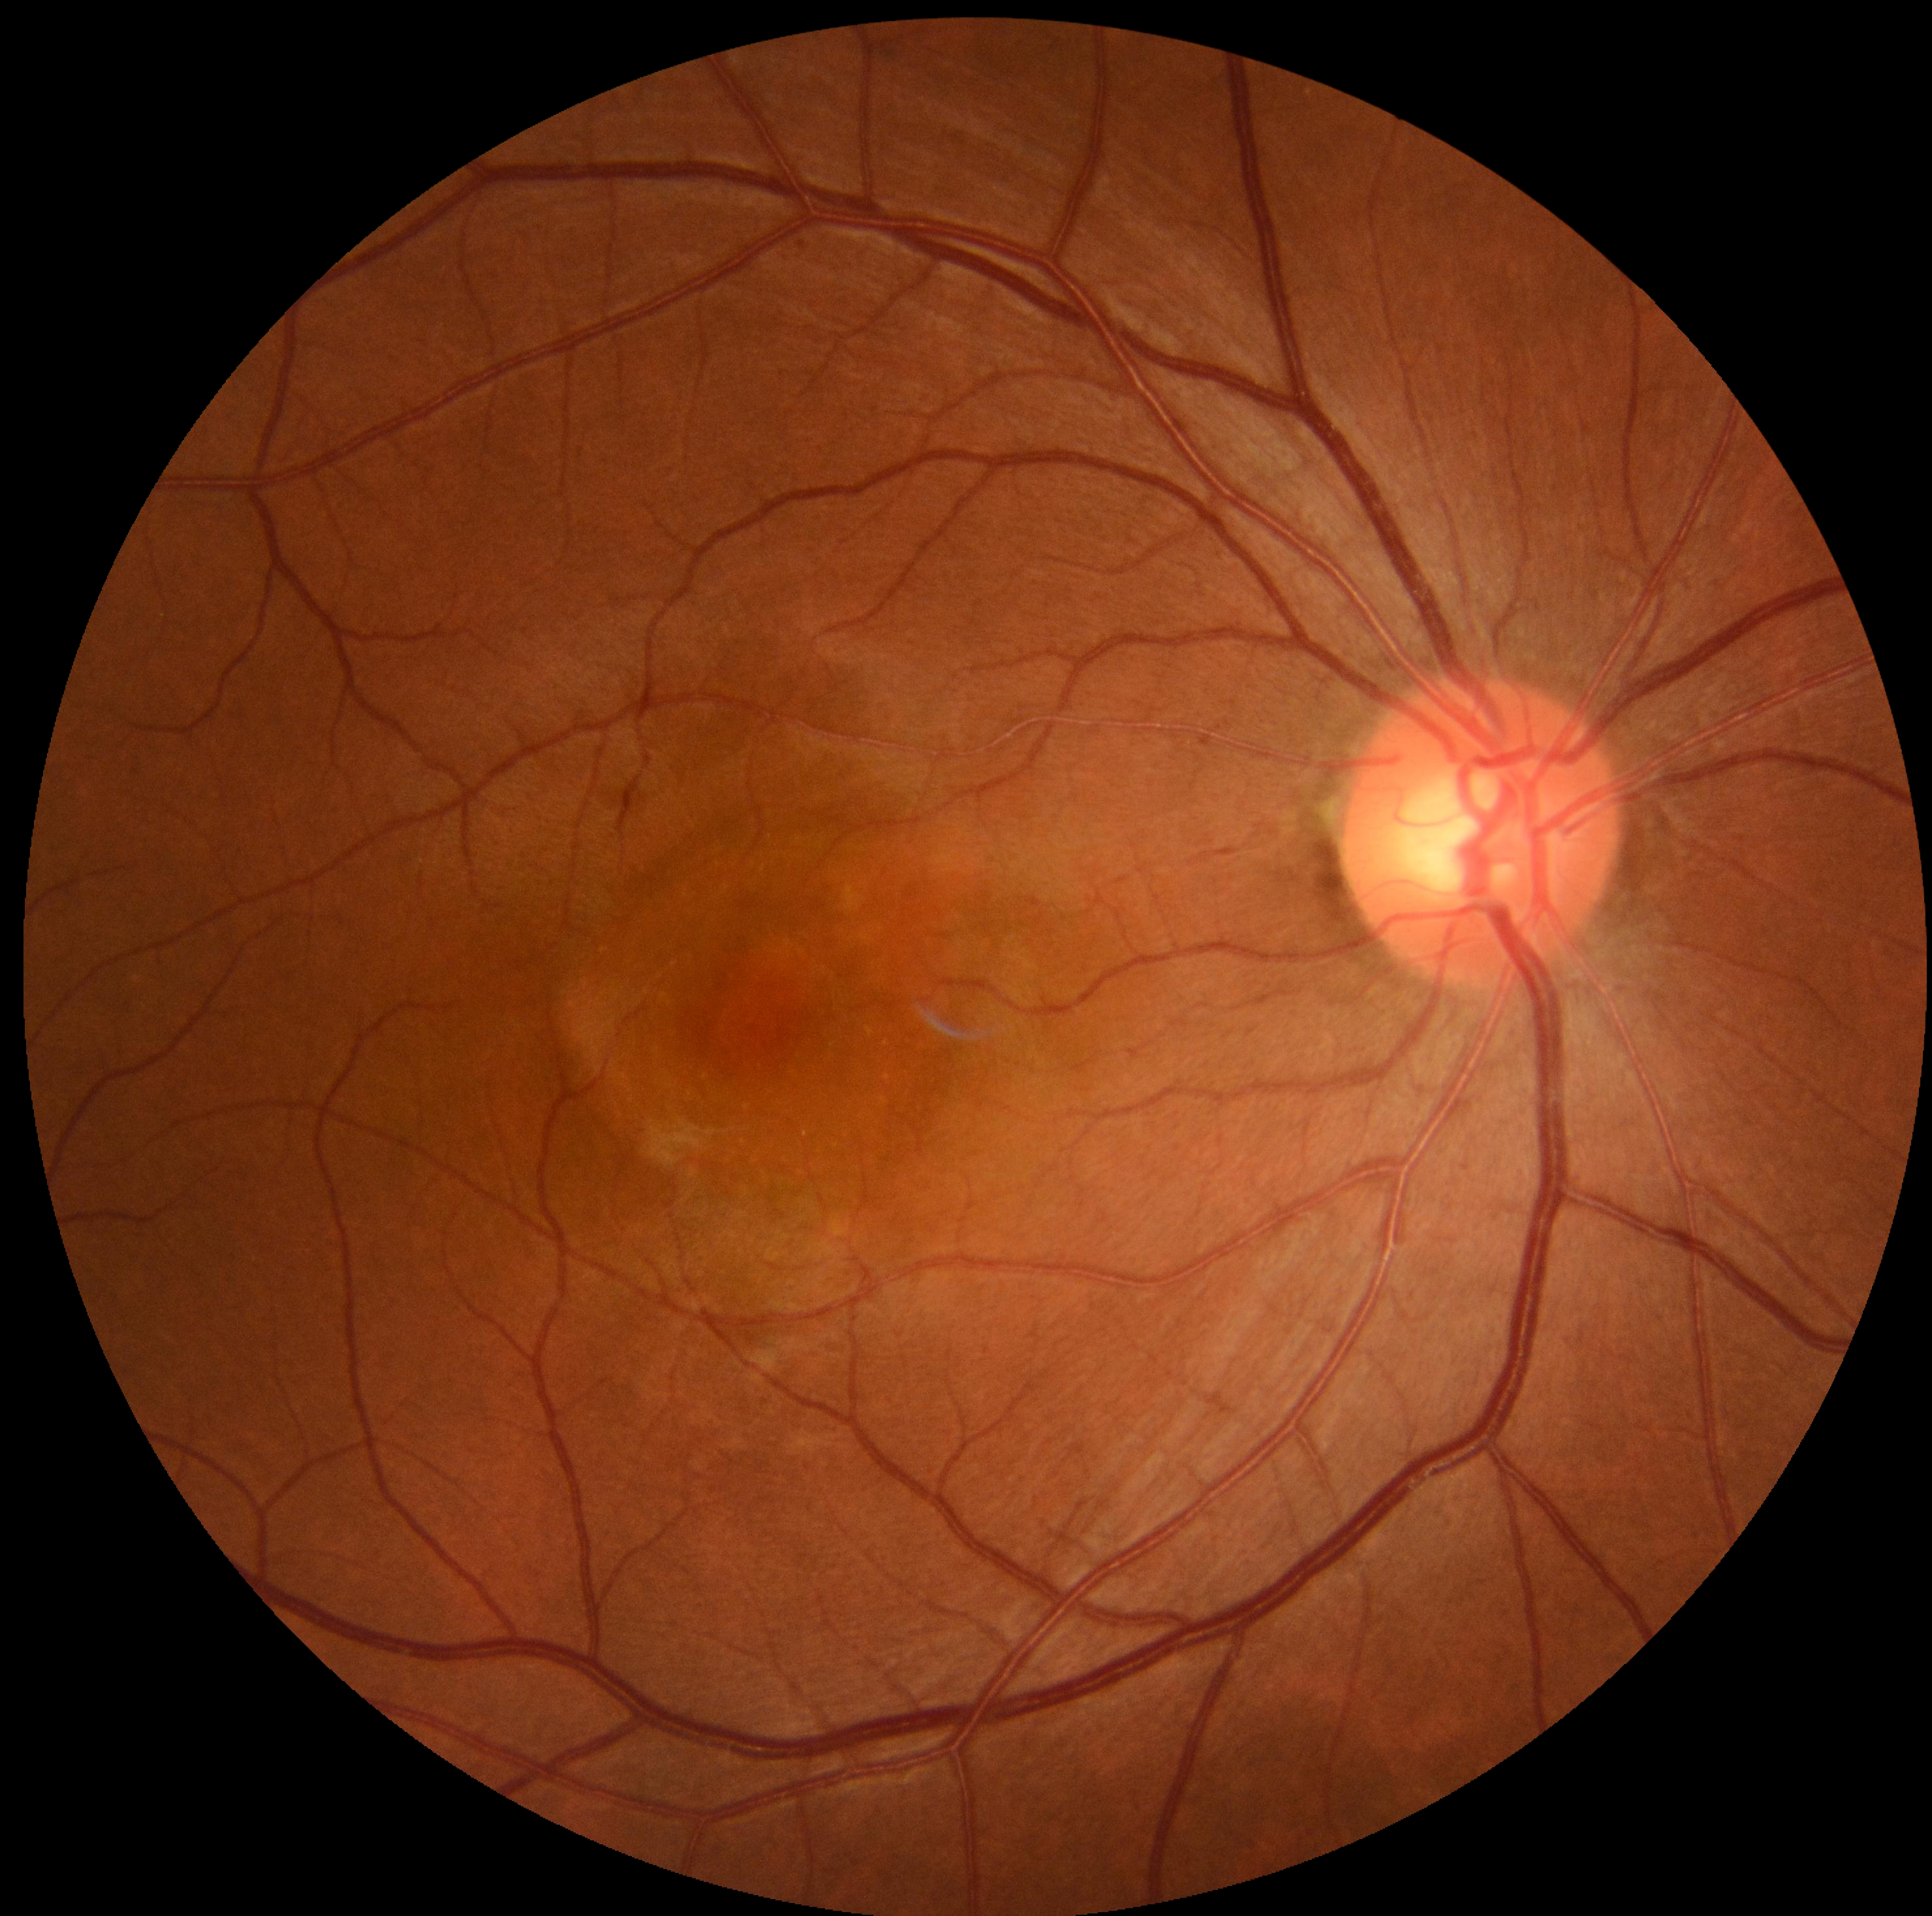

No apparent diabetic retinopathy.
Retinopathy is grade 0 (no apparent retinopathy).